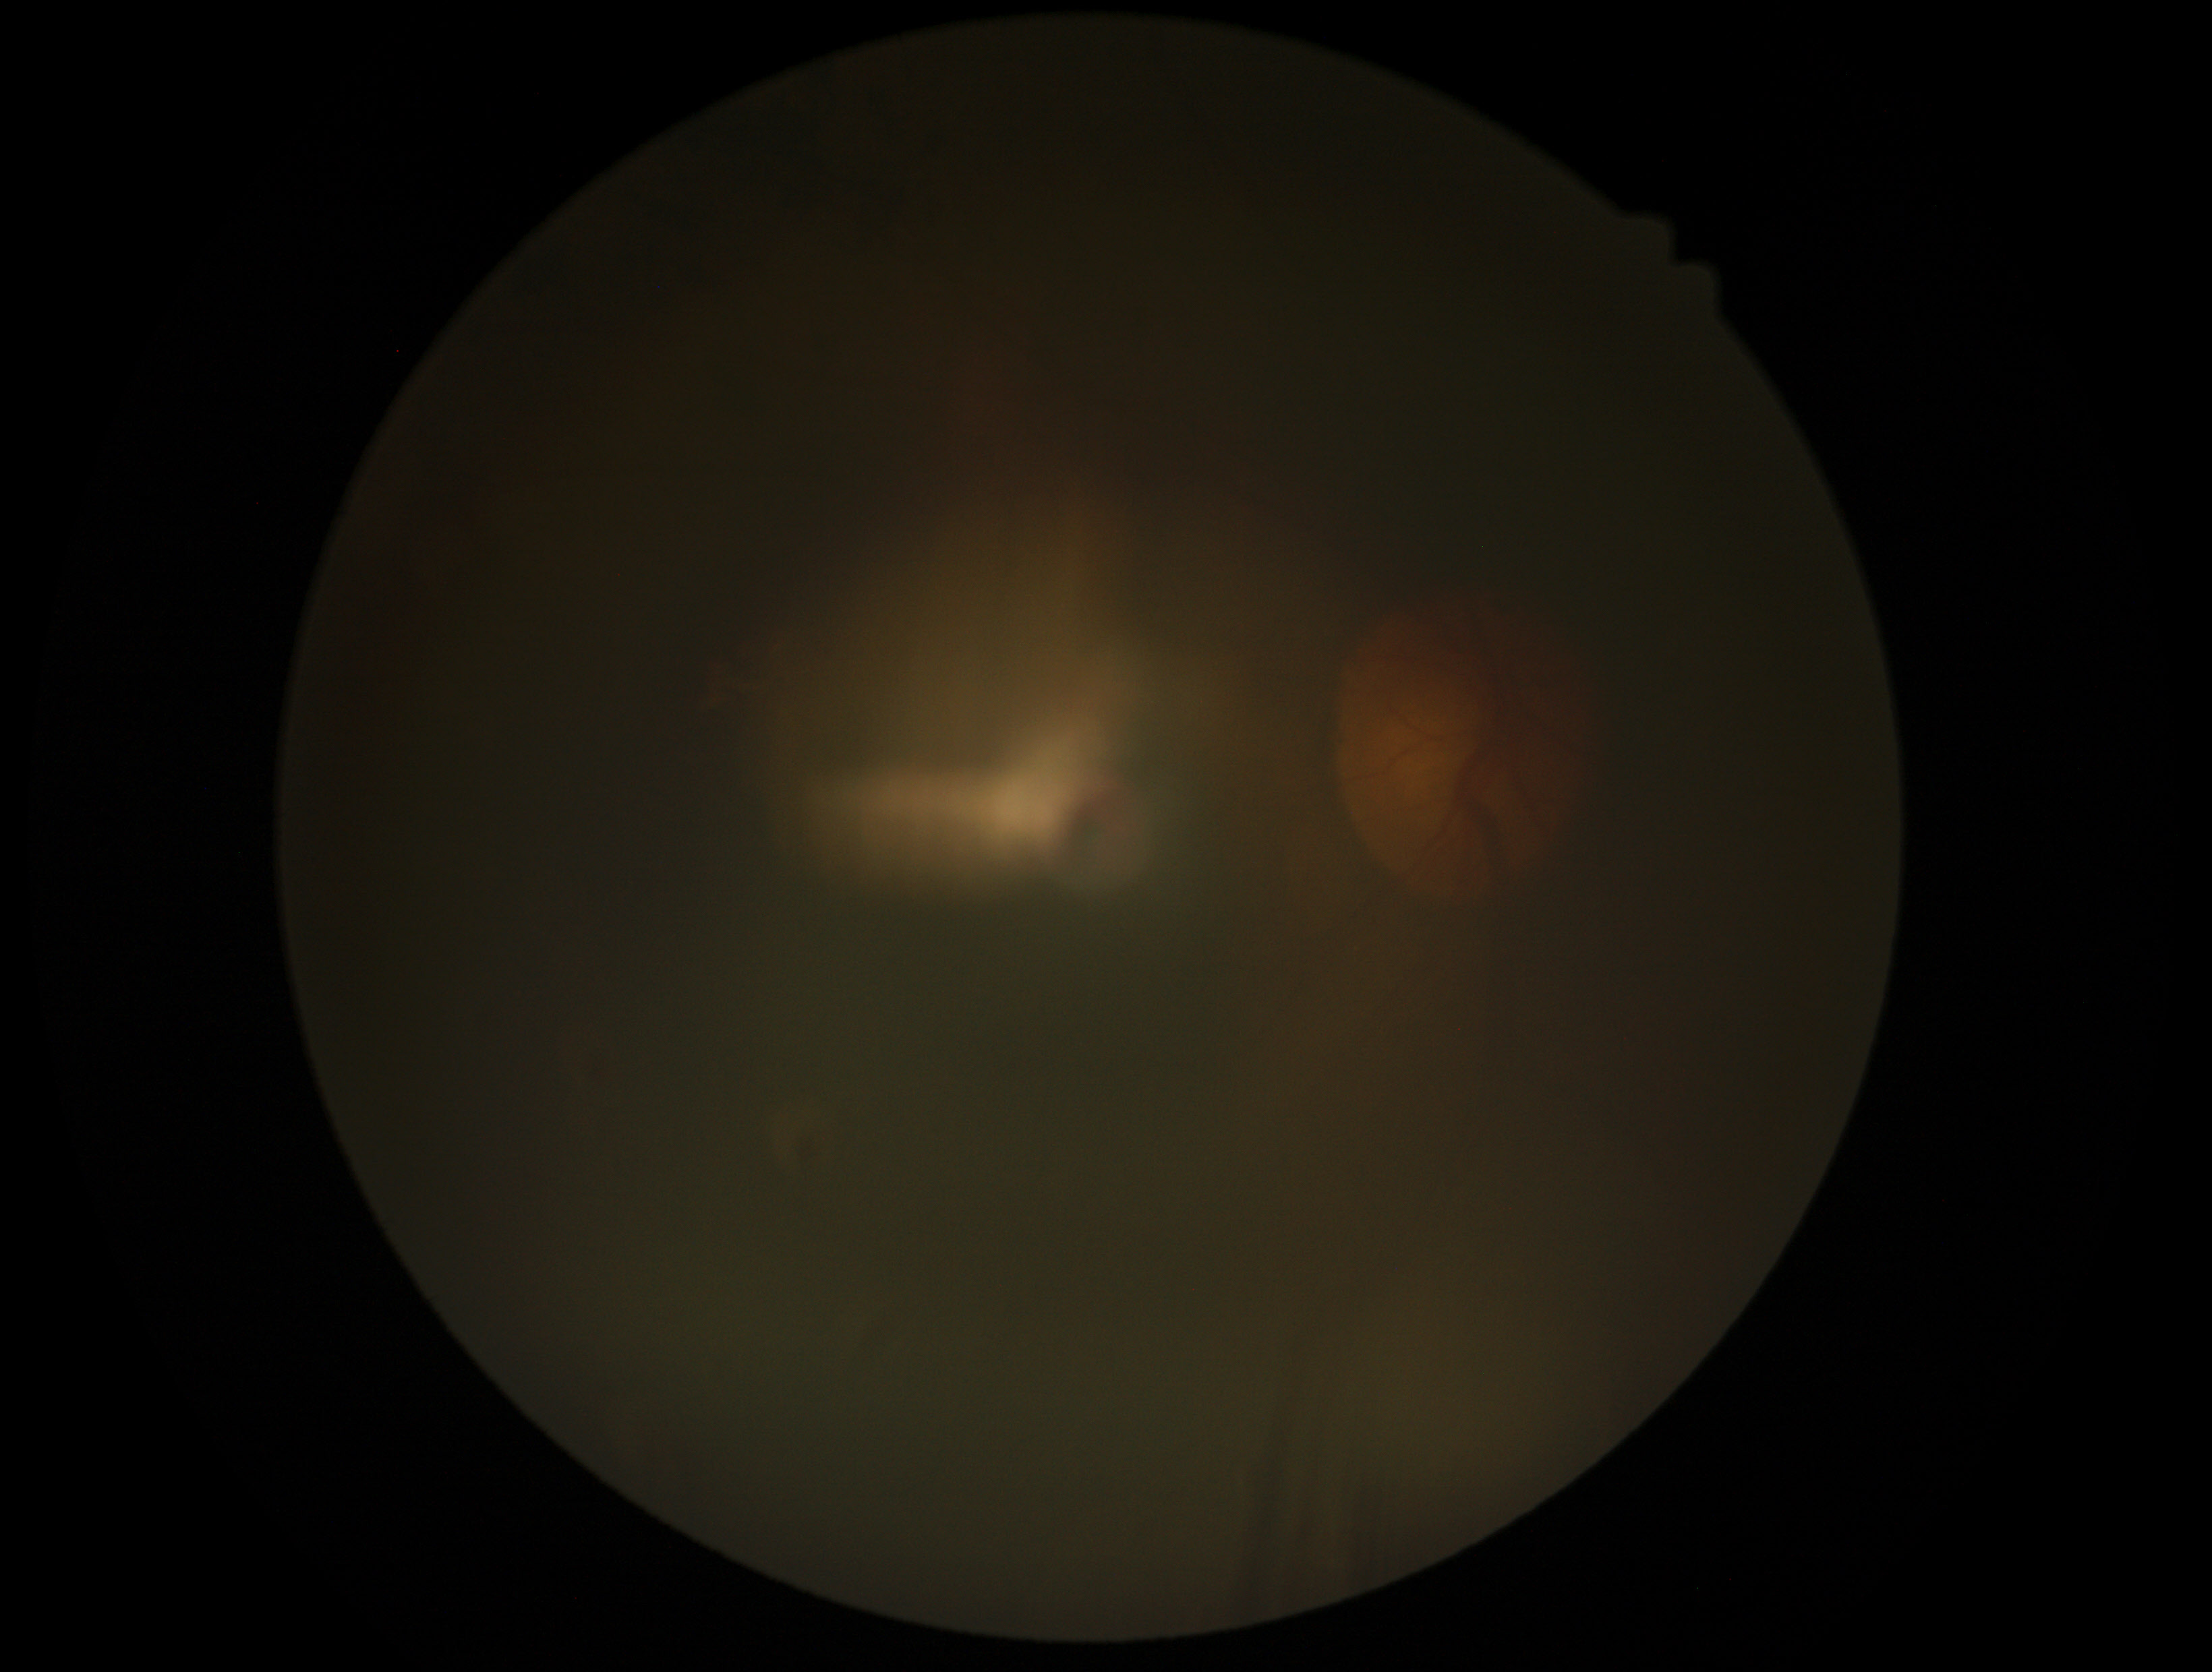

image quality@insufficient for DR assessment, DR severity@ungradable.